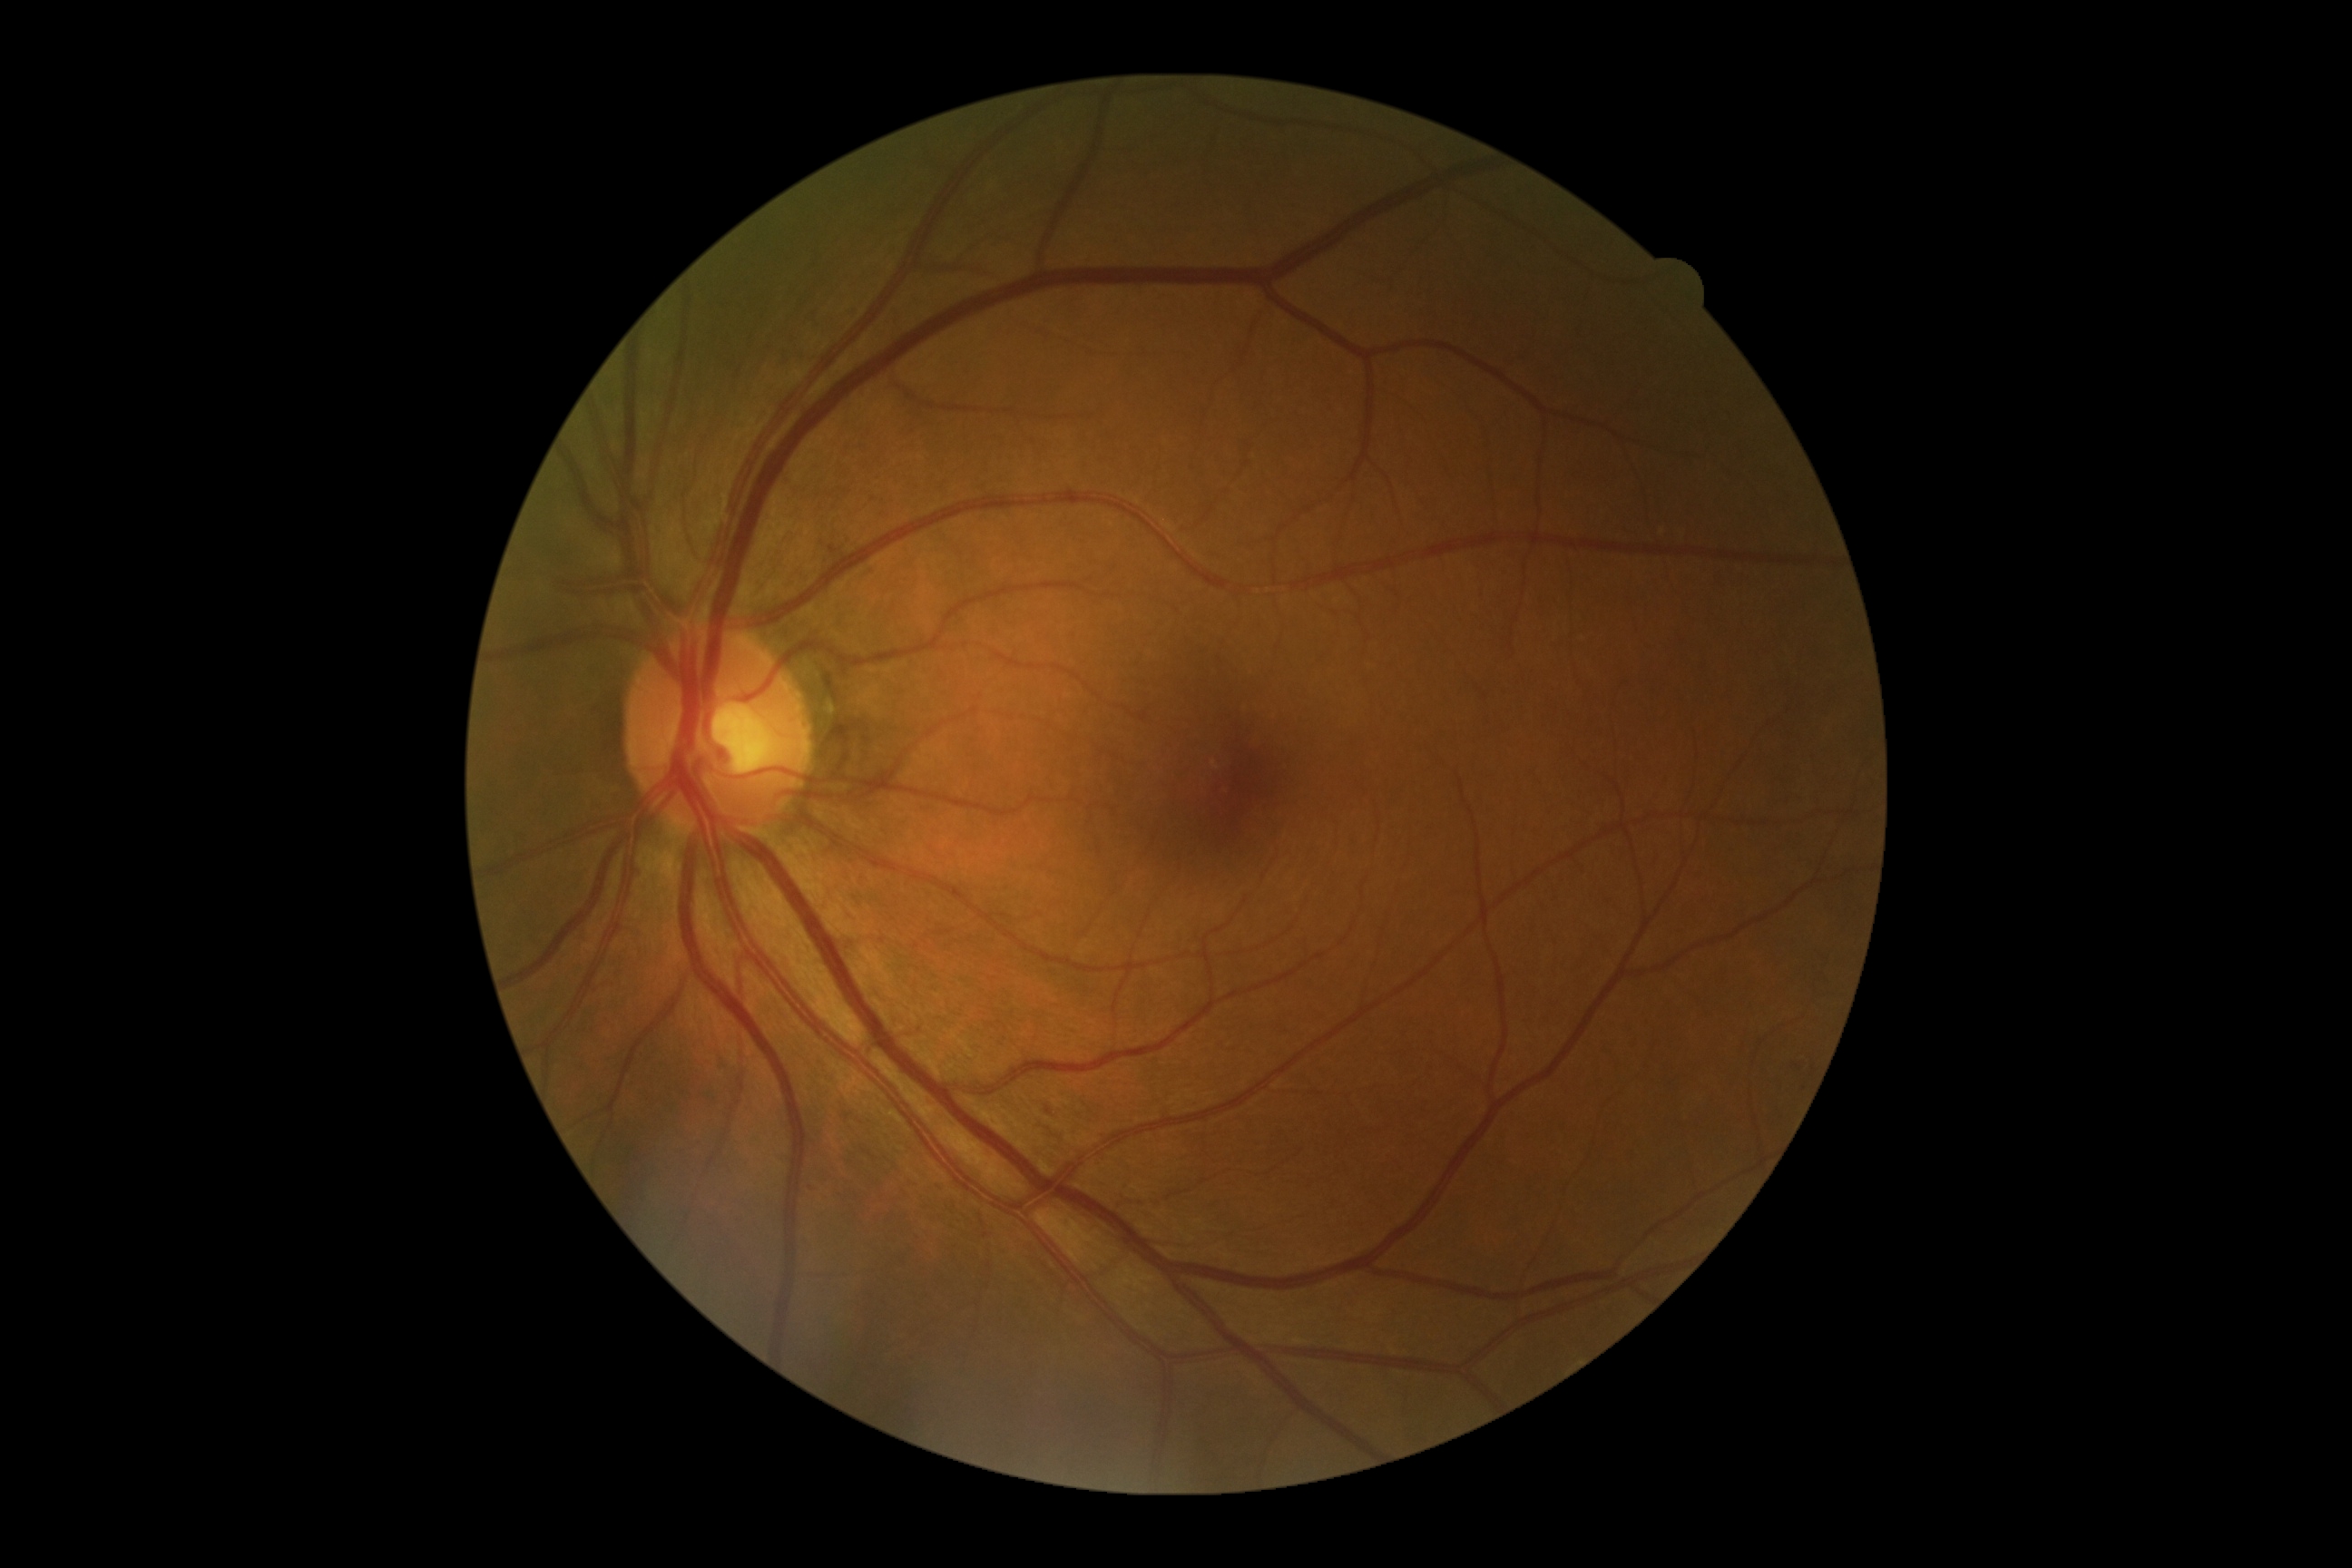

{
  "dr_grade": "mild non-proliferative diabetic retinopathy (grade 1)"
}